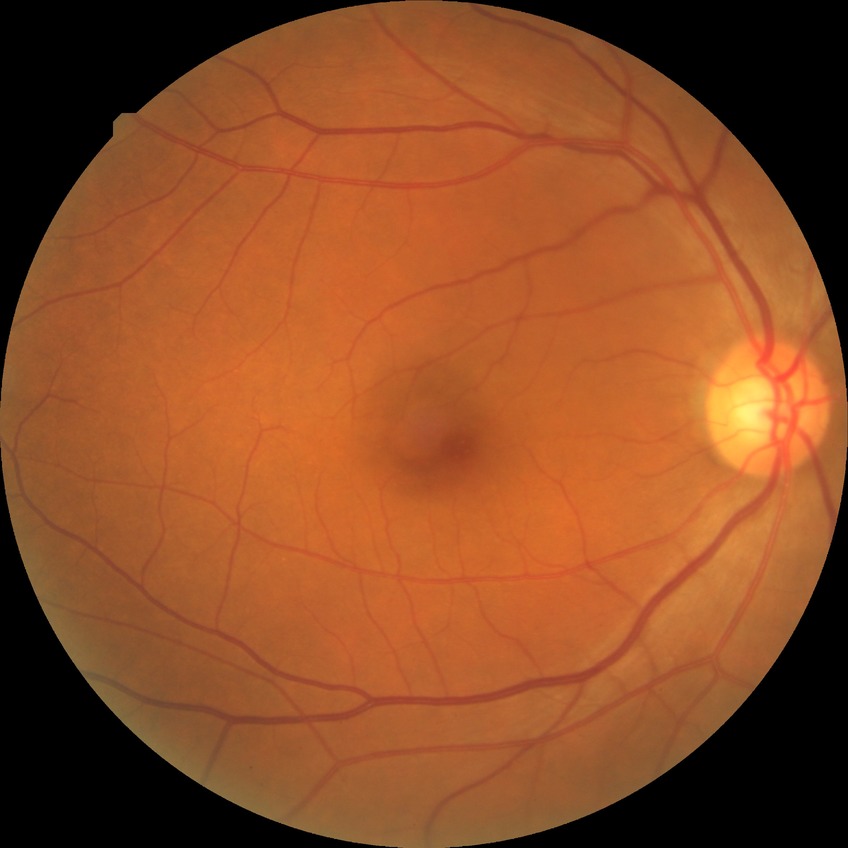 Diabetic retinopathy (DR) is no diabetic retinopathy (NDR).